Retinal fundus photograph. 2212 by 1659 pixels. 45° field of view:
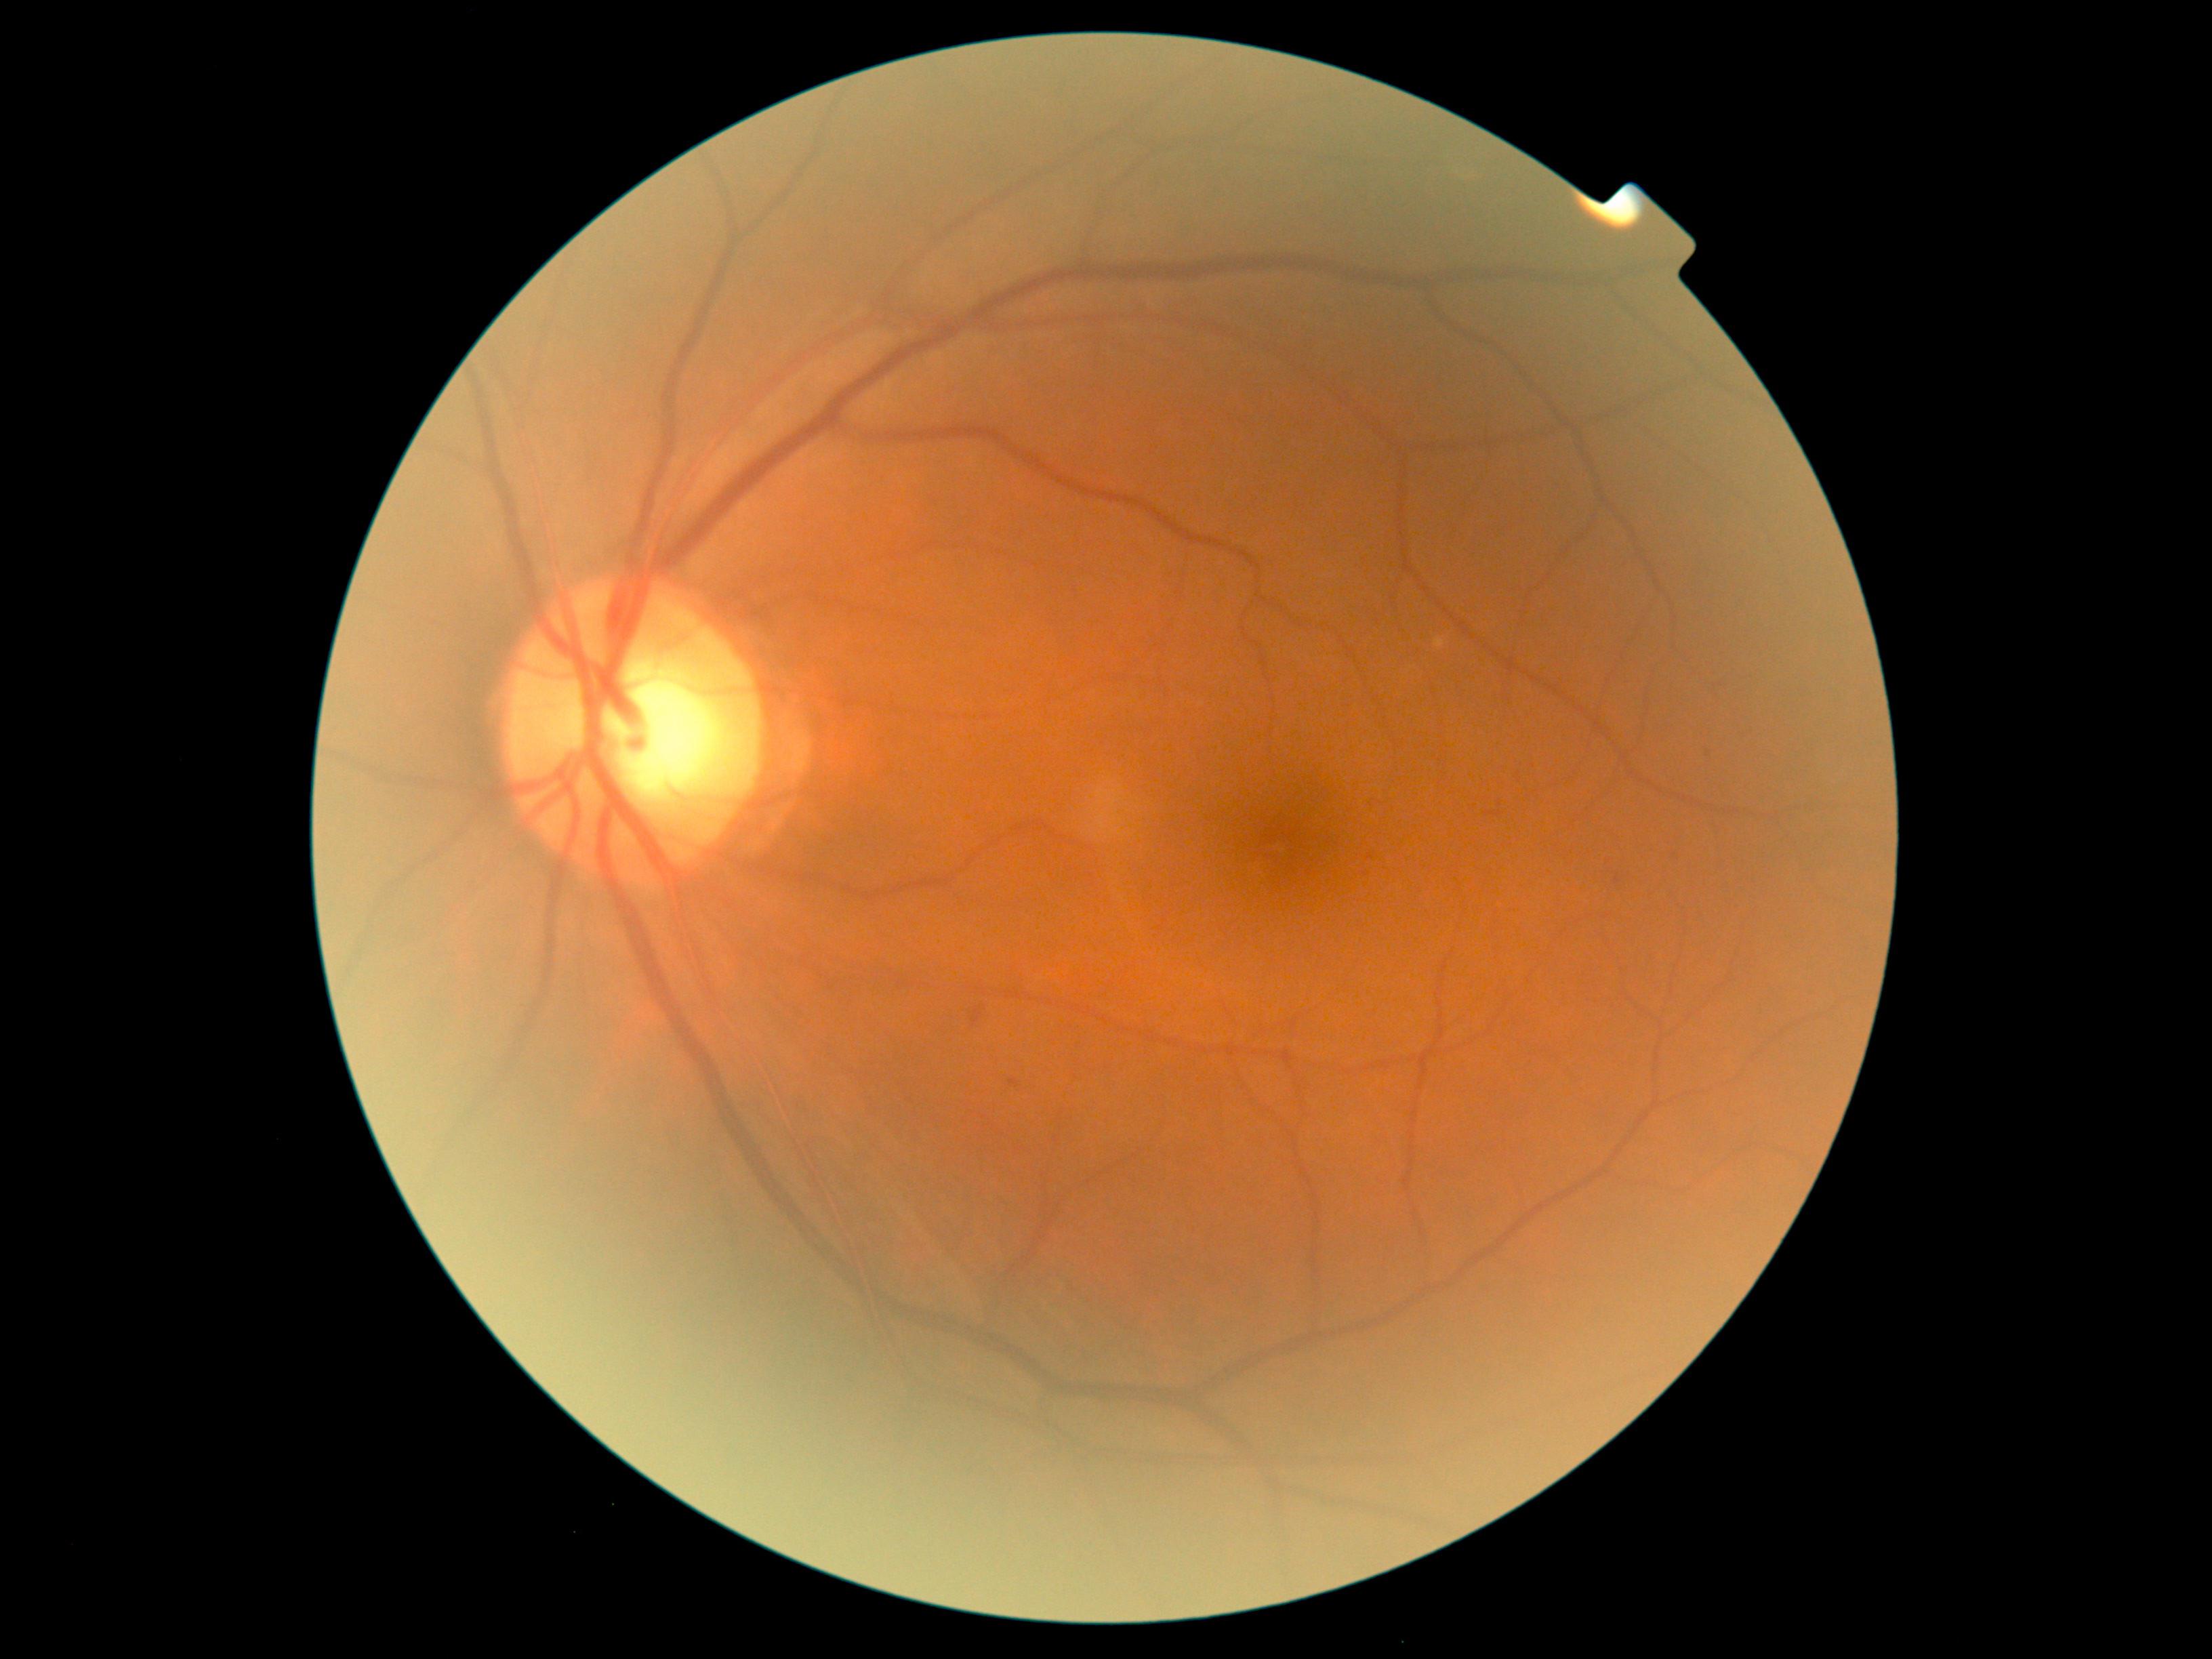
DR grade: 1 (mild NPDR).